Fundus photo. FOV: 45 degrees: 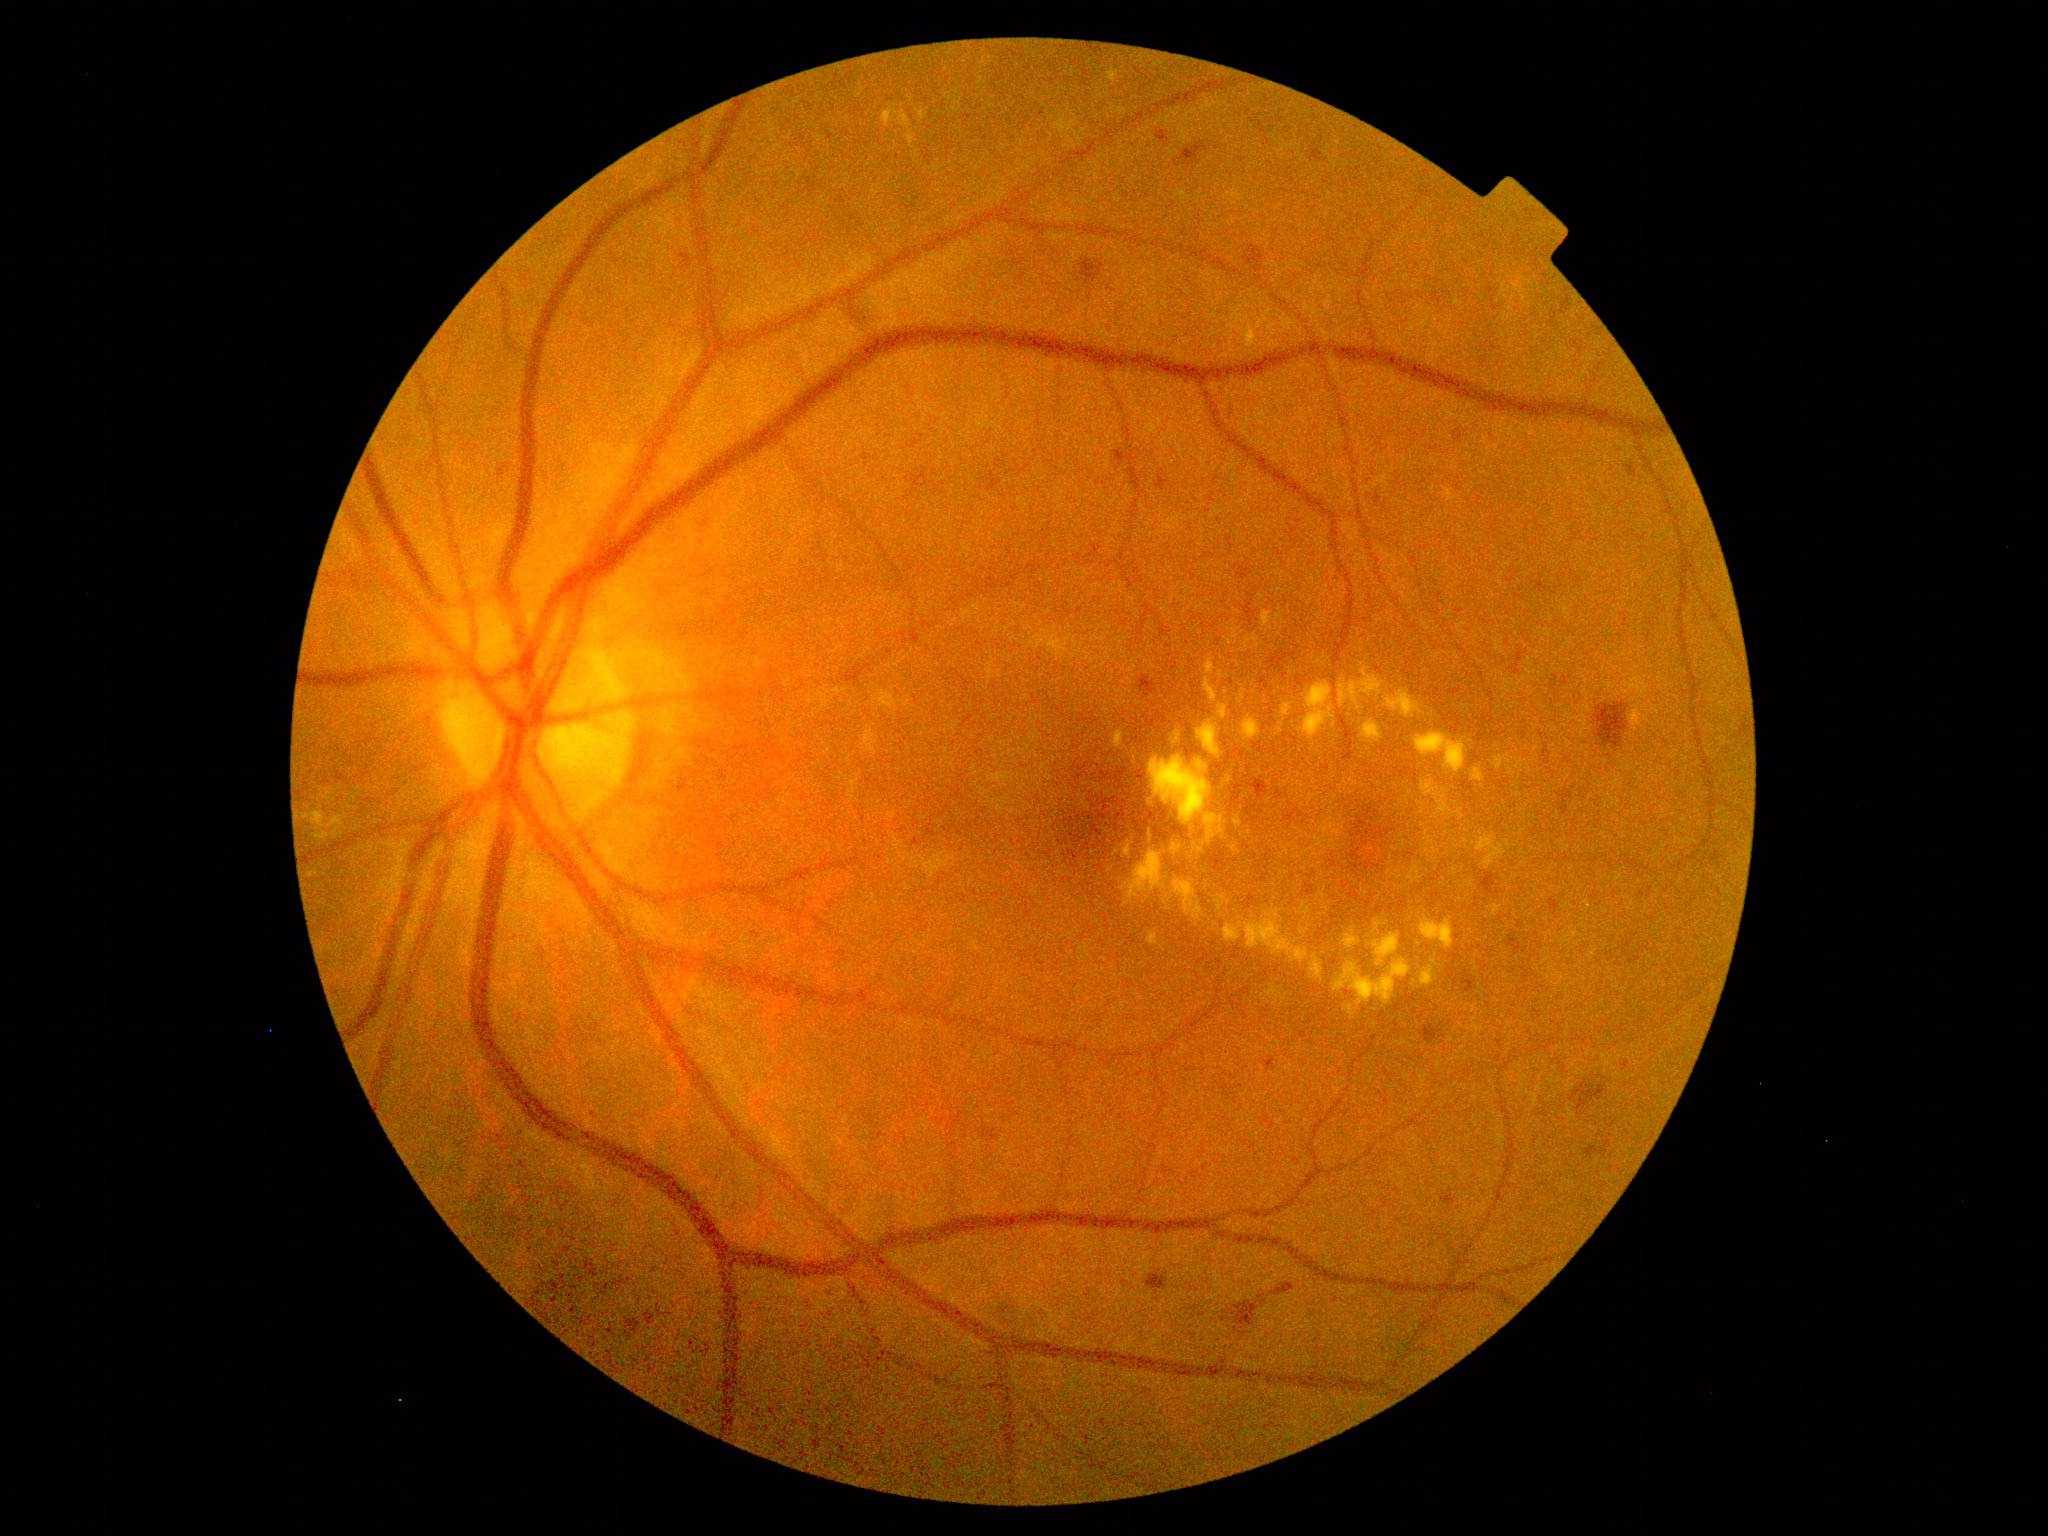
Diabetic retinopathy (DR): 2. Hard exudates (EXs) include lesions at bbox=[1320, 891, 1327, 899]; bbox=[1144, 896, 1149, 904]; bbox=[1115, 700, 1132, 707]; bbox=[1112, 730, 1125, 752]; bbox=[1493, 755, 1516, 776]; bbox=[1338, 670, 1384, 711]; bbox=[1315, 818, 1343, 851]; bbox=[1314, 852, 1325, 859]; bbox=[1489, 905, 1502, 918]. Small EXs near [1458,847]; [1249,833]; [1326,909]; [1341,787]; [1475,1008]; [1116,1010]; [1399,873]; [1205,1005]; [1511,740]; [1202,996].